Retinal fundus photograph: 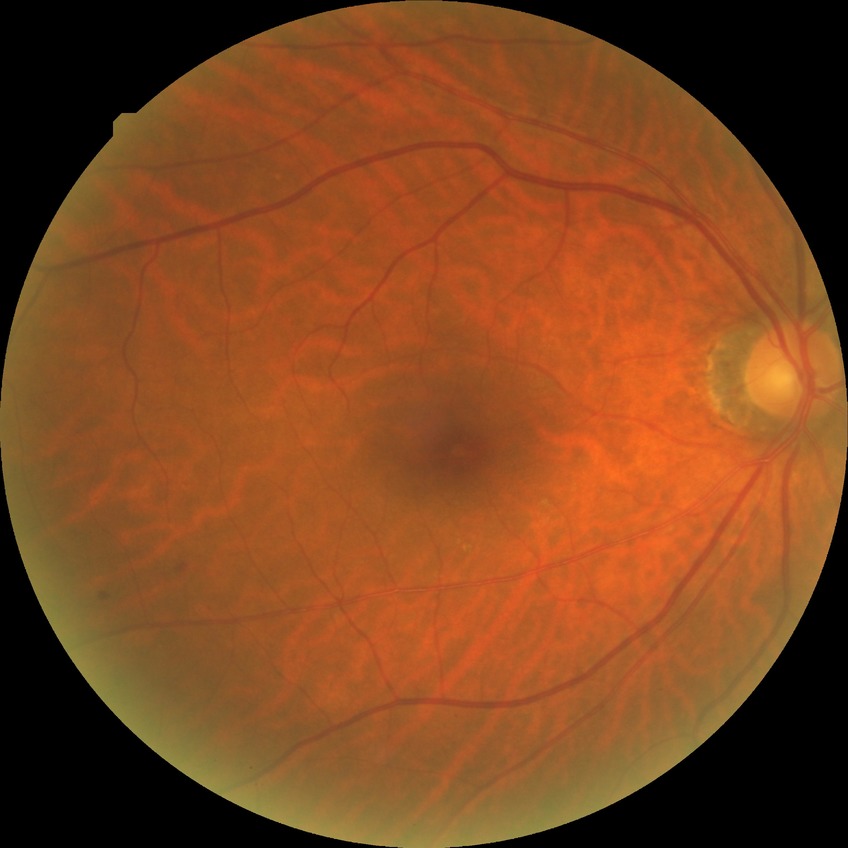 Diabetic retinopathy (DR): SDR (simple diabetic retinopathy).